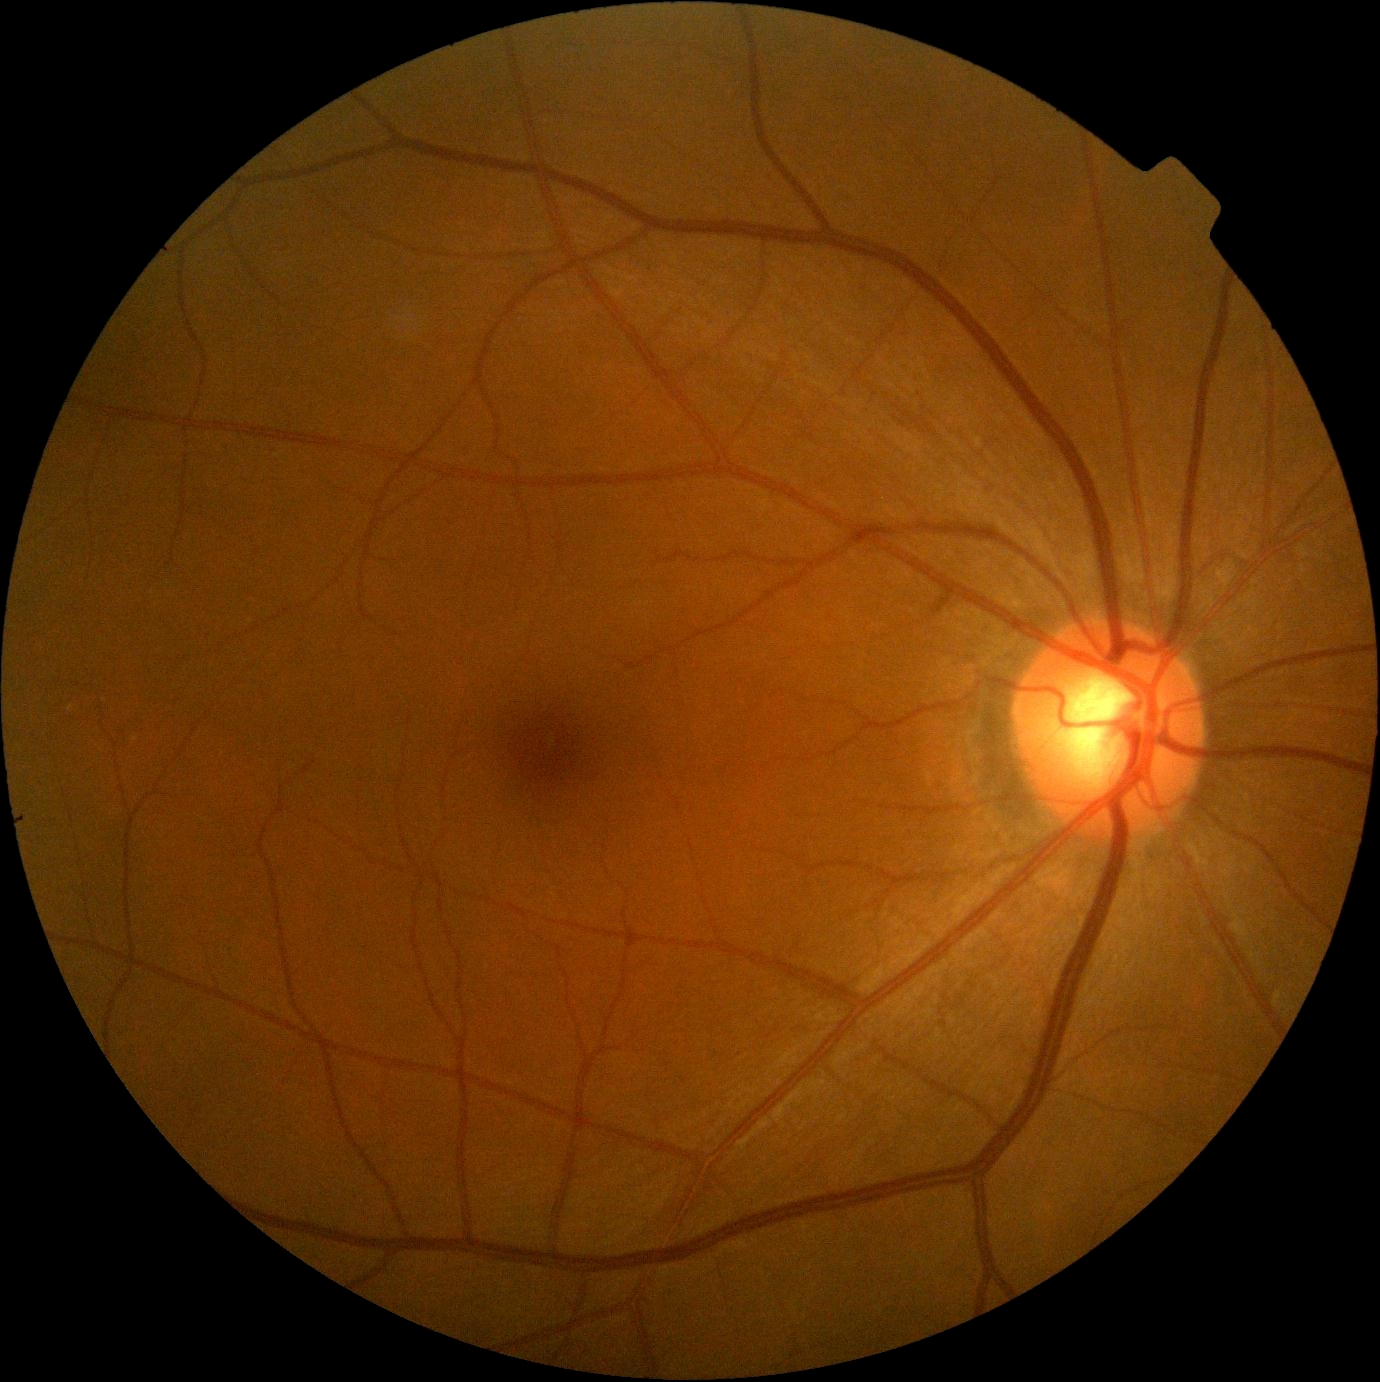

DR severity = grade 0